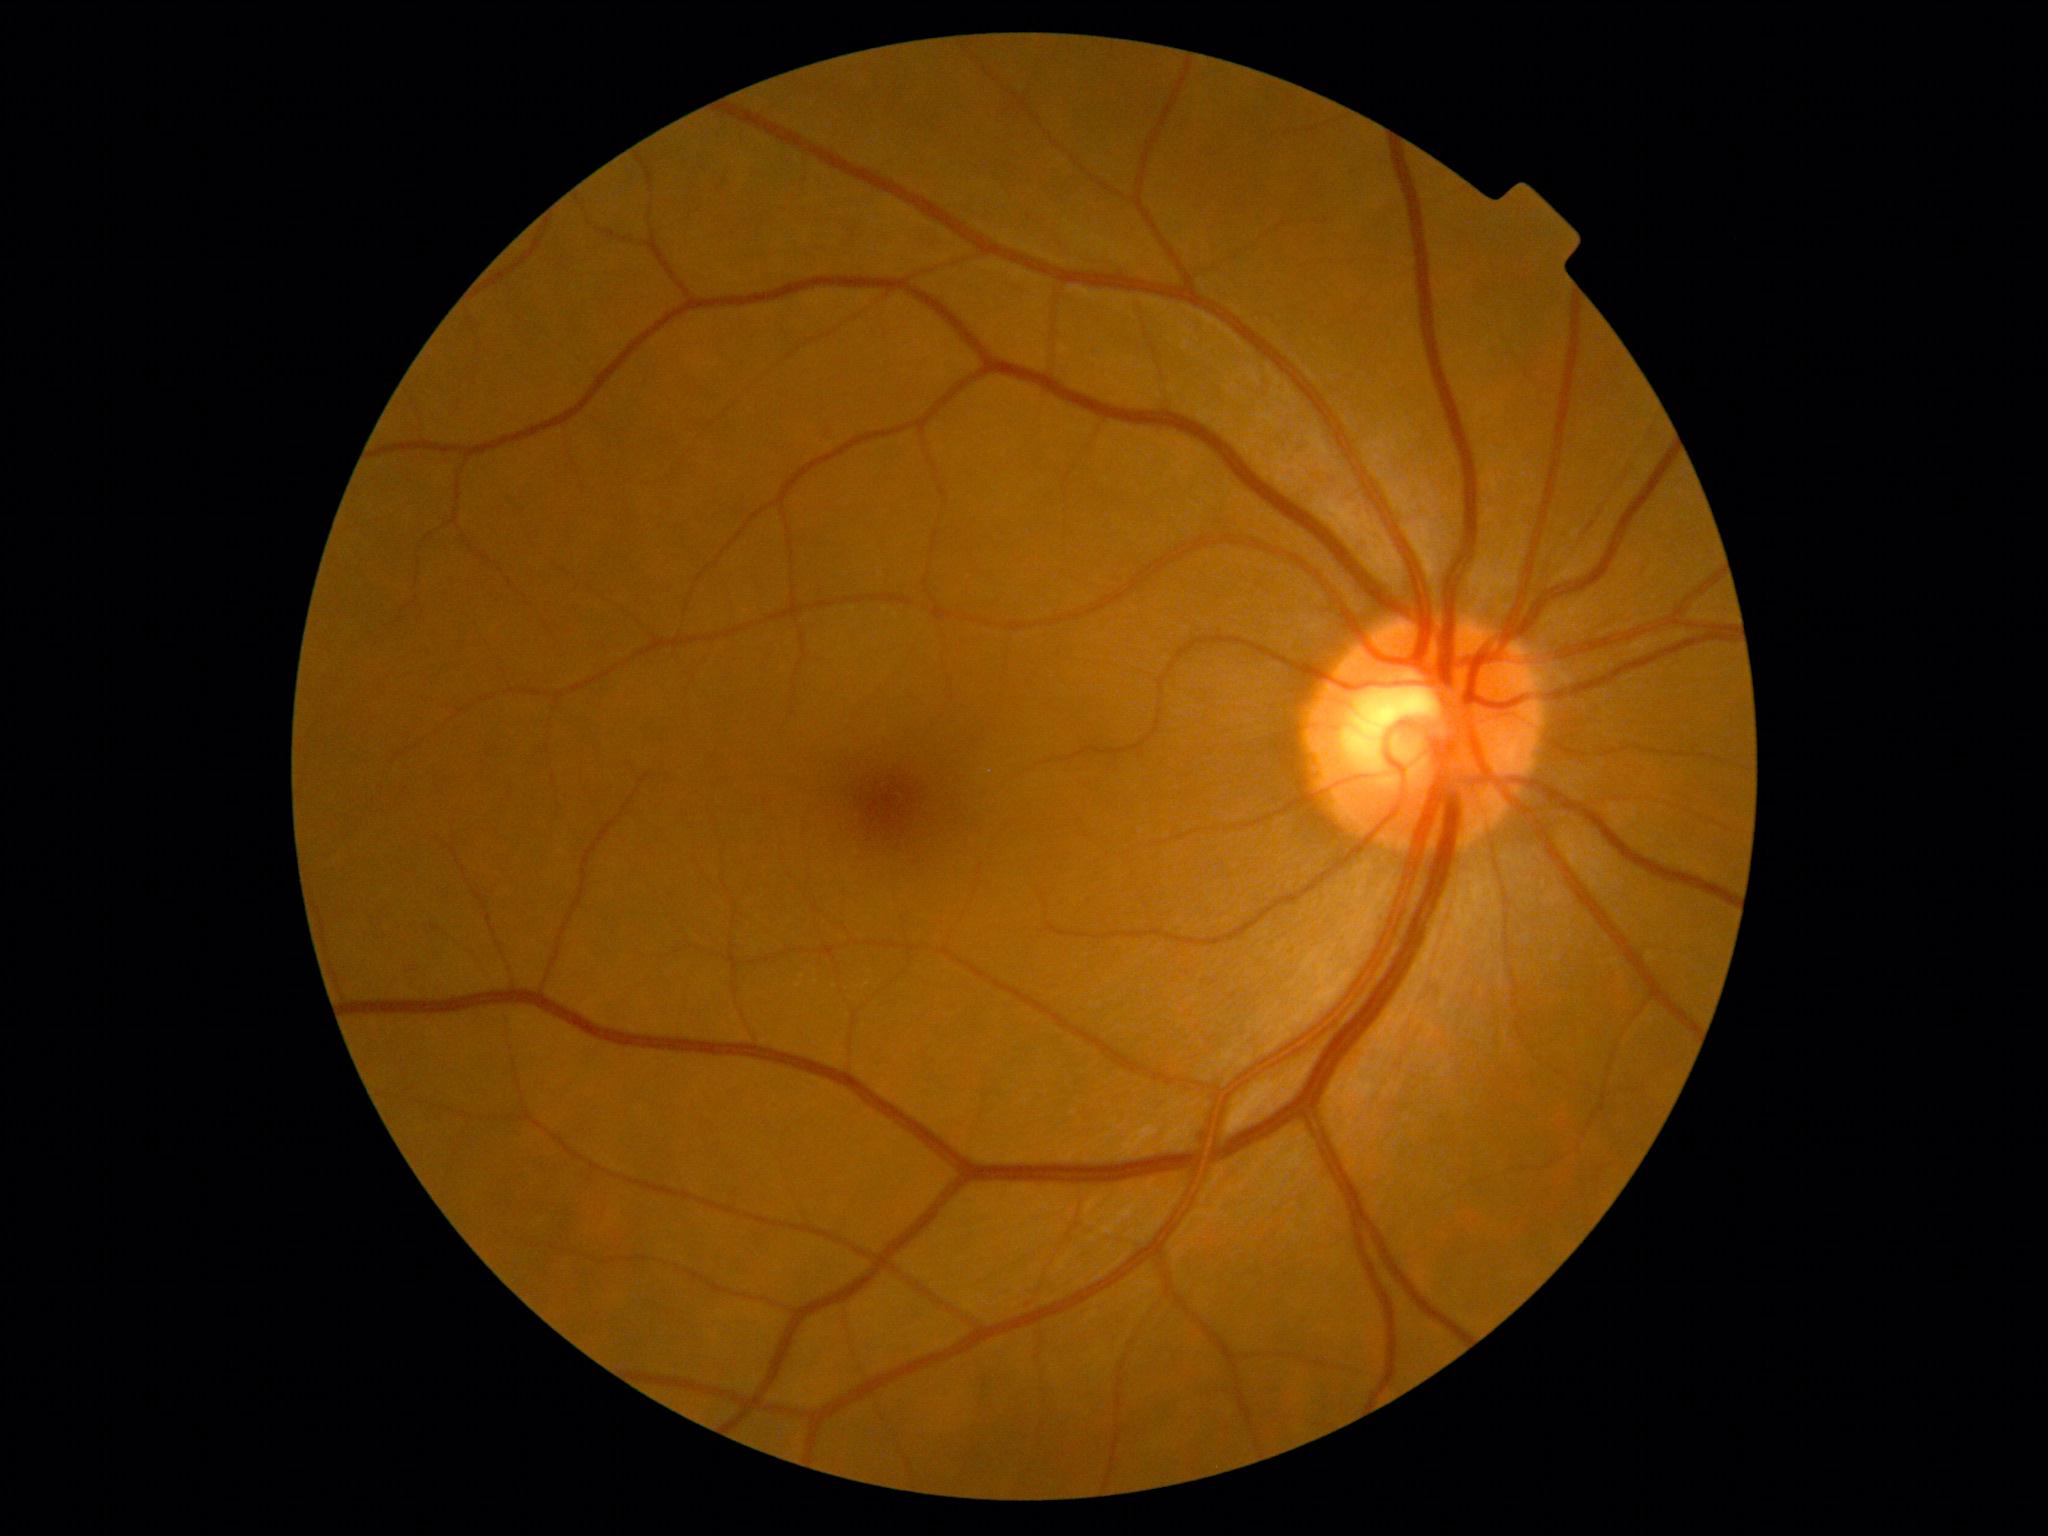
No DR findings. Diabetic retinopathy (DR) is 0.